NIDEK AFC-230; 848x848px — 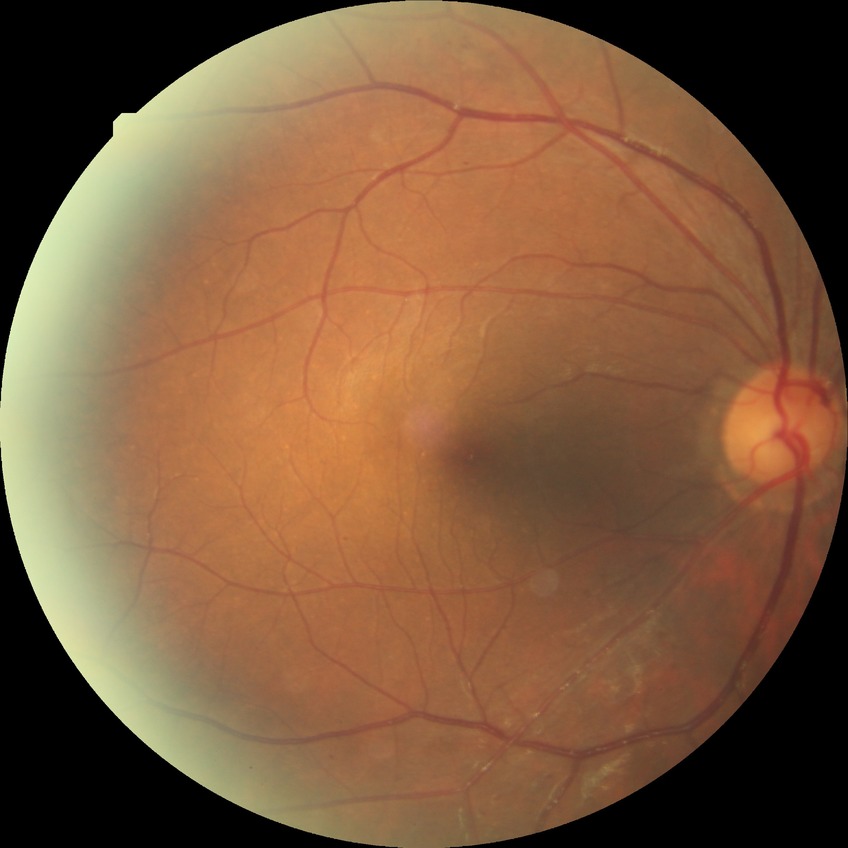
  davis_grade: simple diabetic retinopathy (SDR)